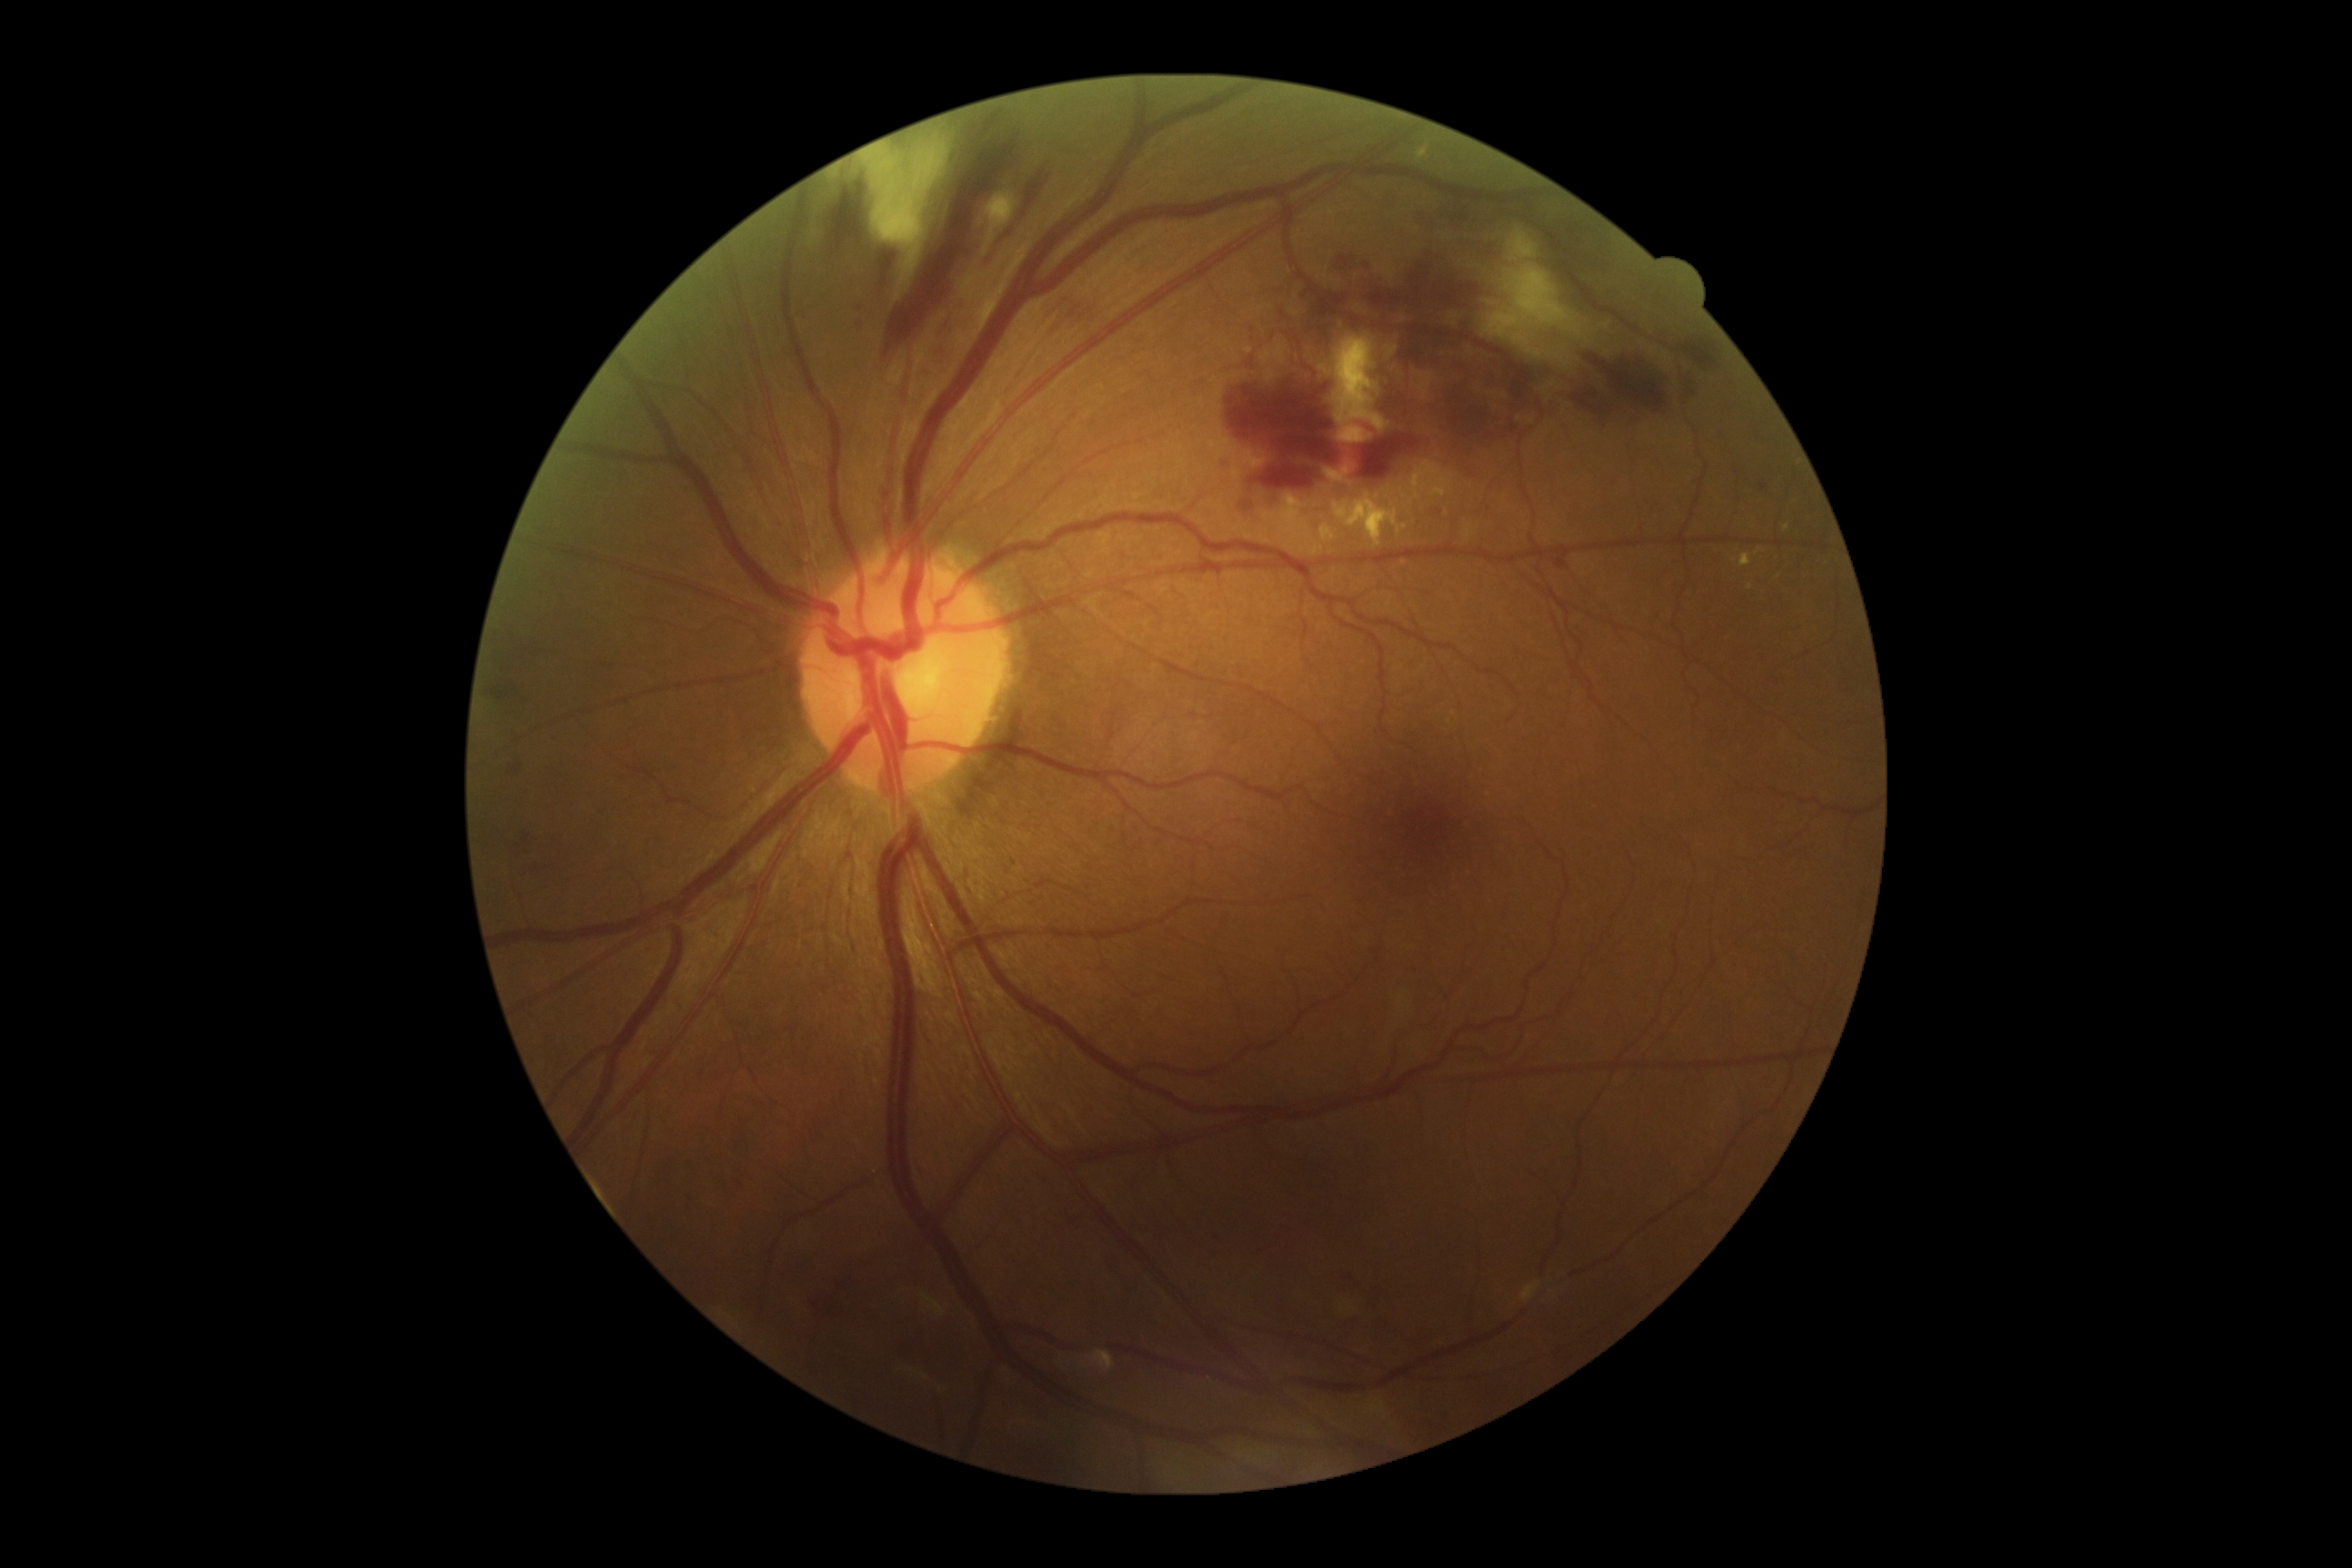

dr_category: non-proliferative diabetic retinopathy
dr_grade: grade 2